Image size 1440x1080 · pediatric retinal photograph (wide-field) · Natus RetCam Envision, 130° FOV — 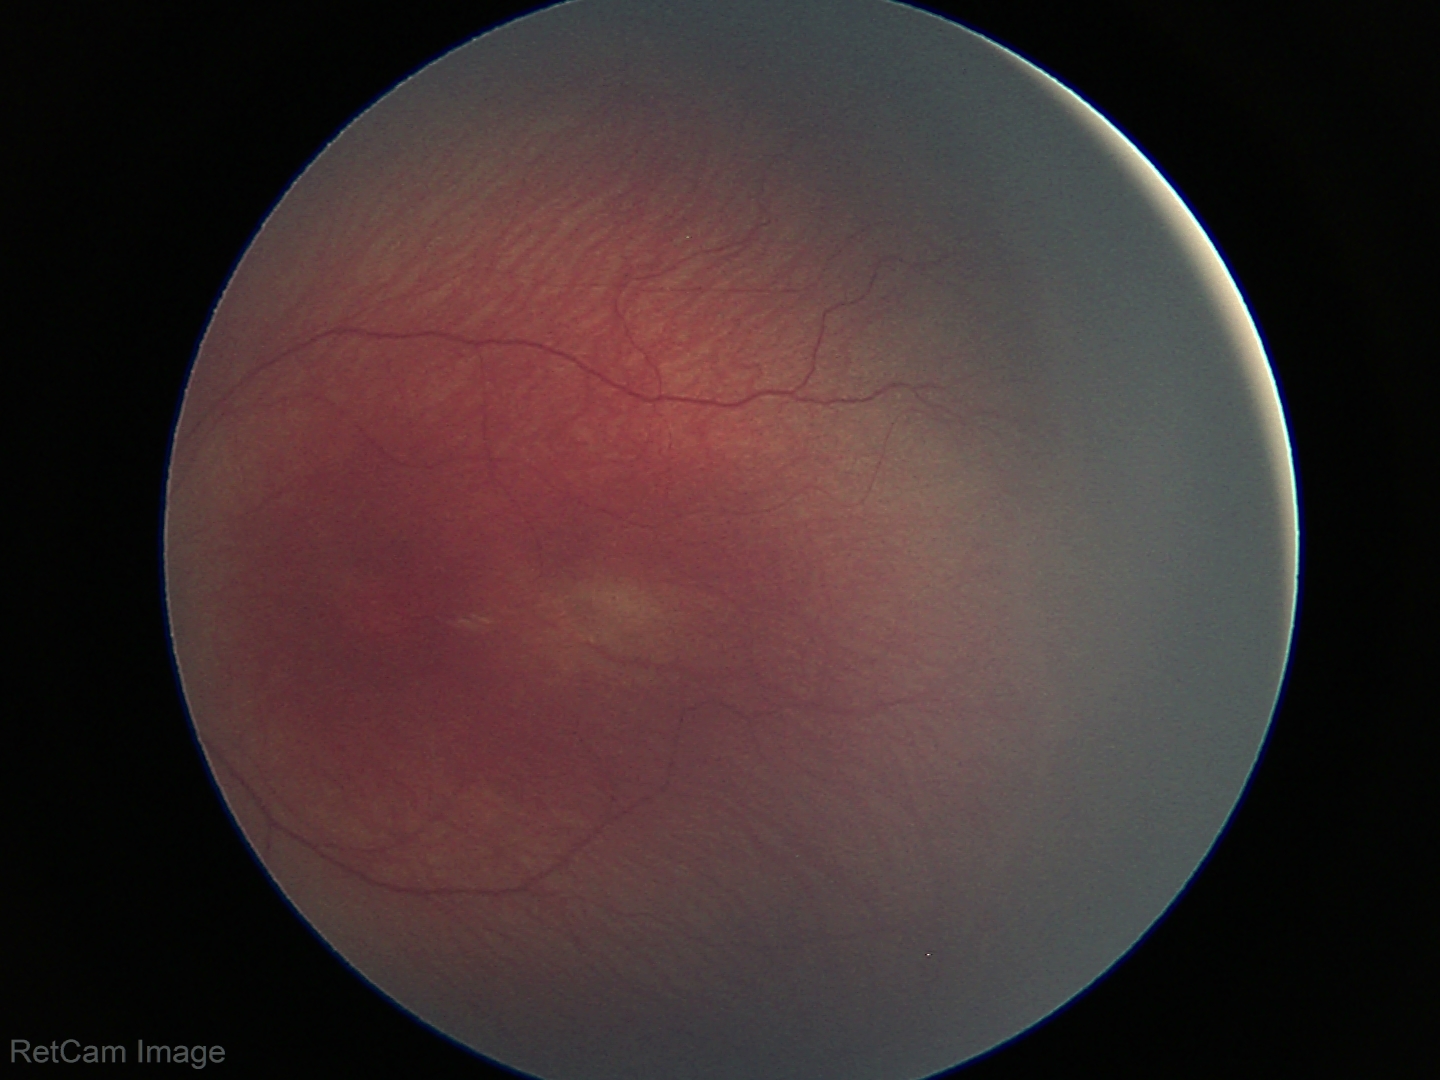
Q: What is the screening diagnosis?
A: ROP stage 1
Q: What is the plus-form classification?
A: no plus disease